848x848px.
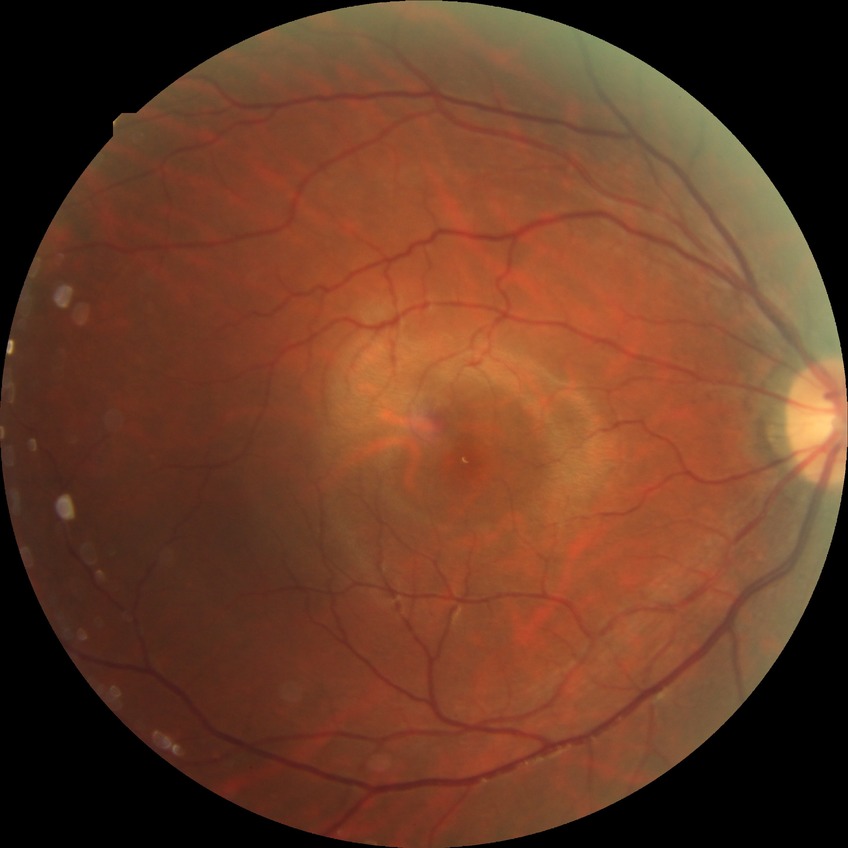 - diabetic retinopathy grade: no diabetic retinopathy